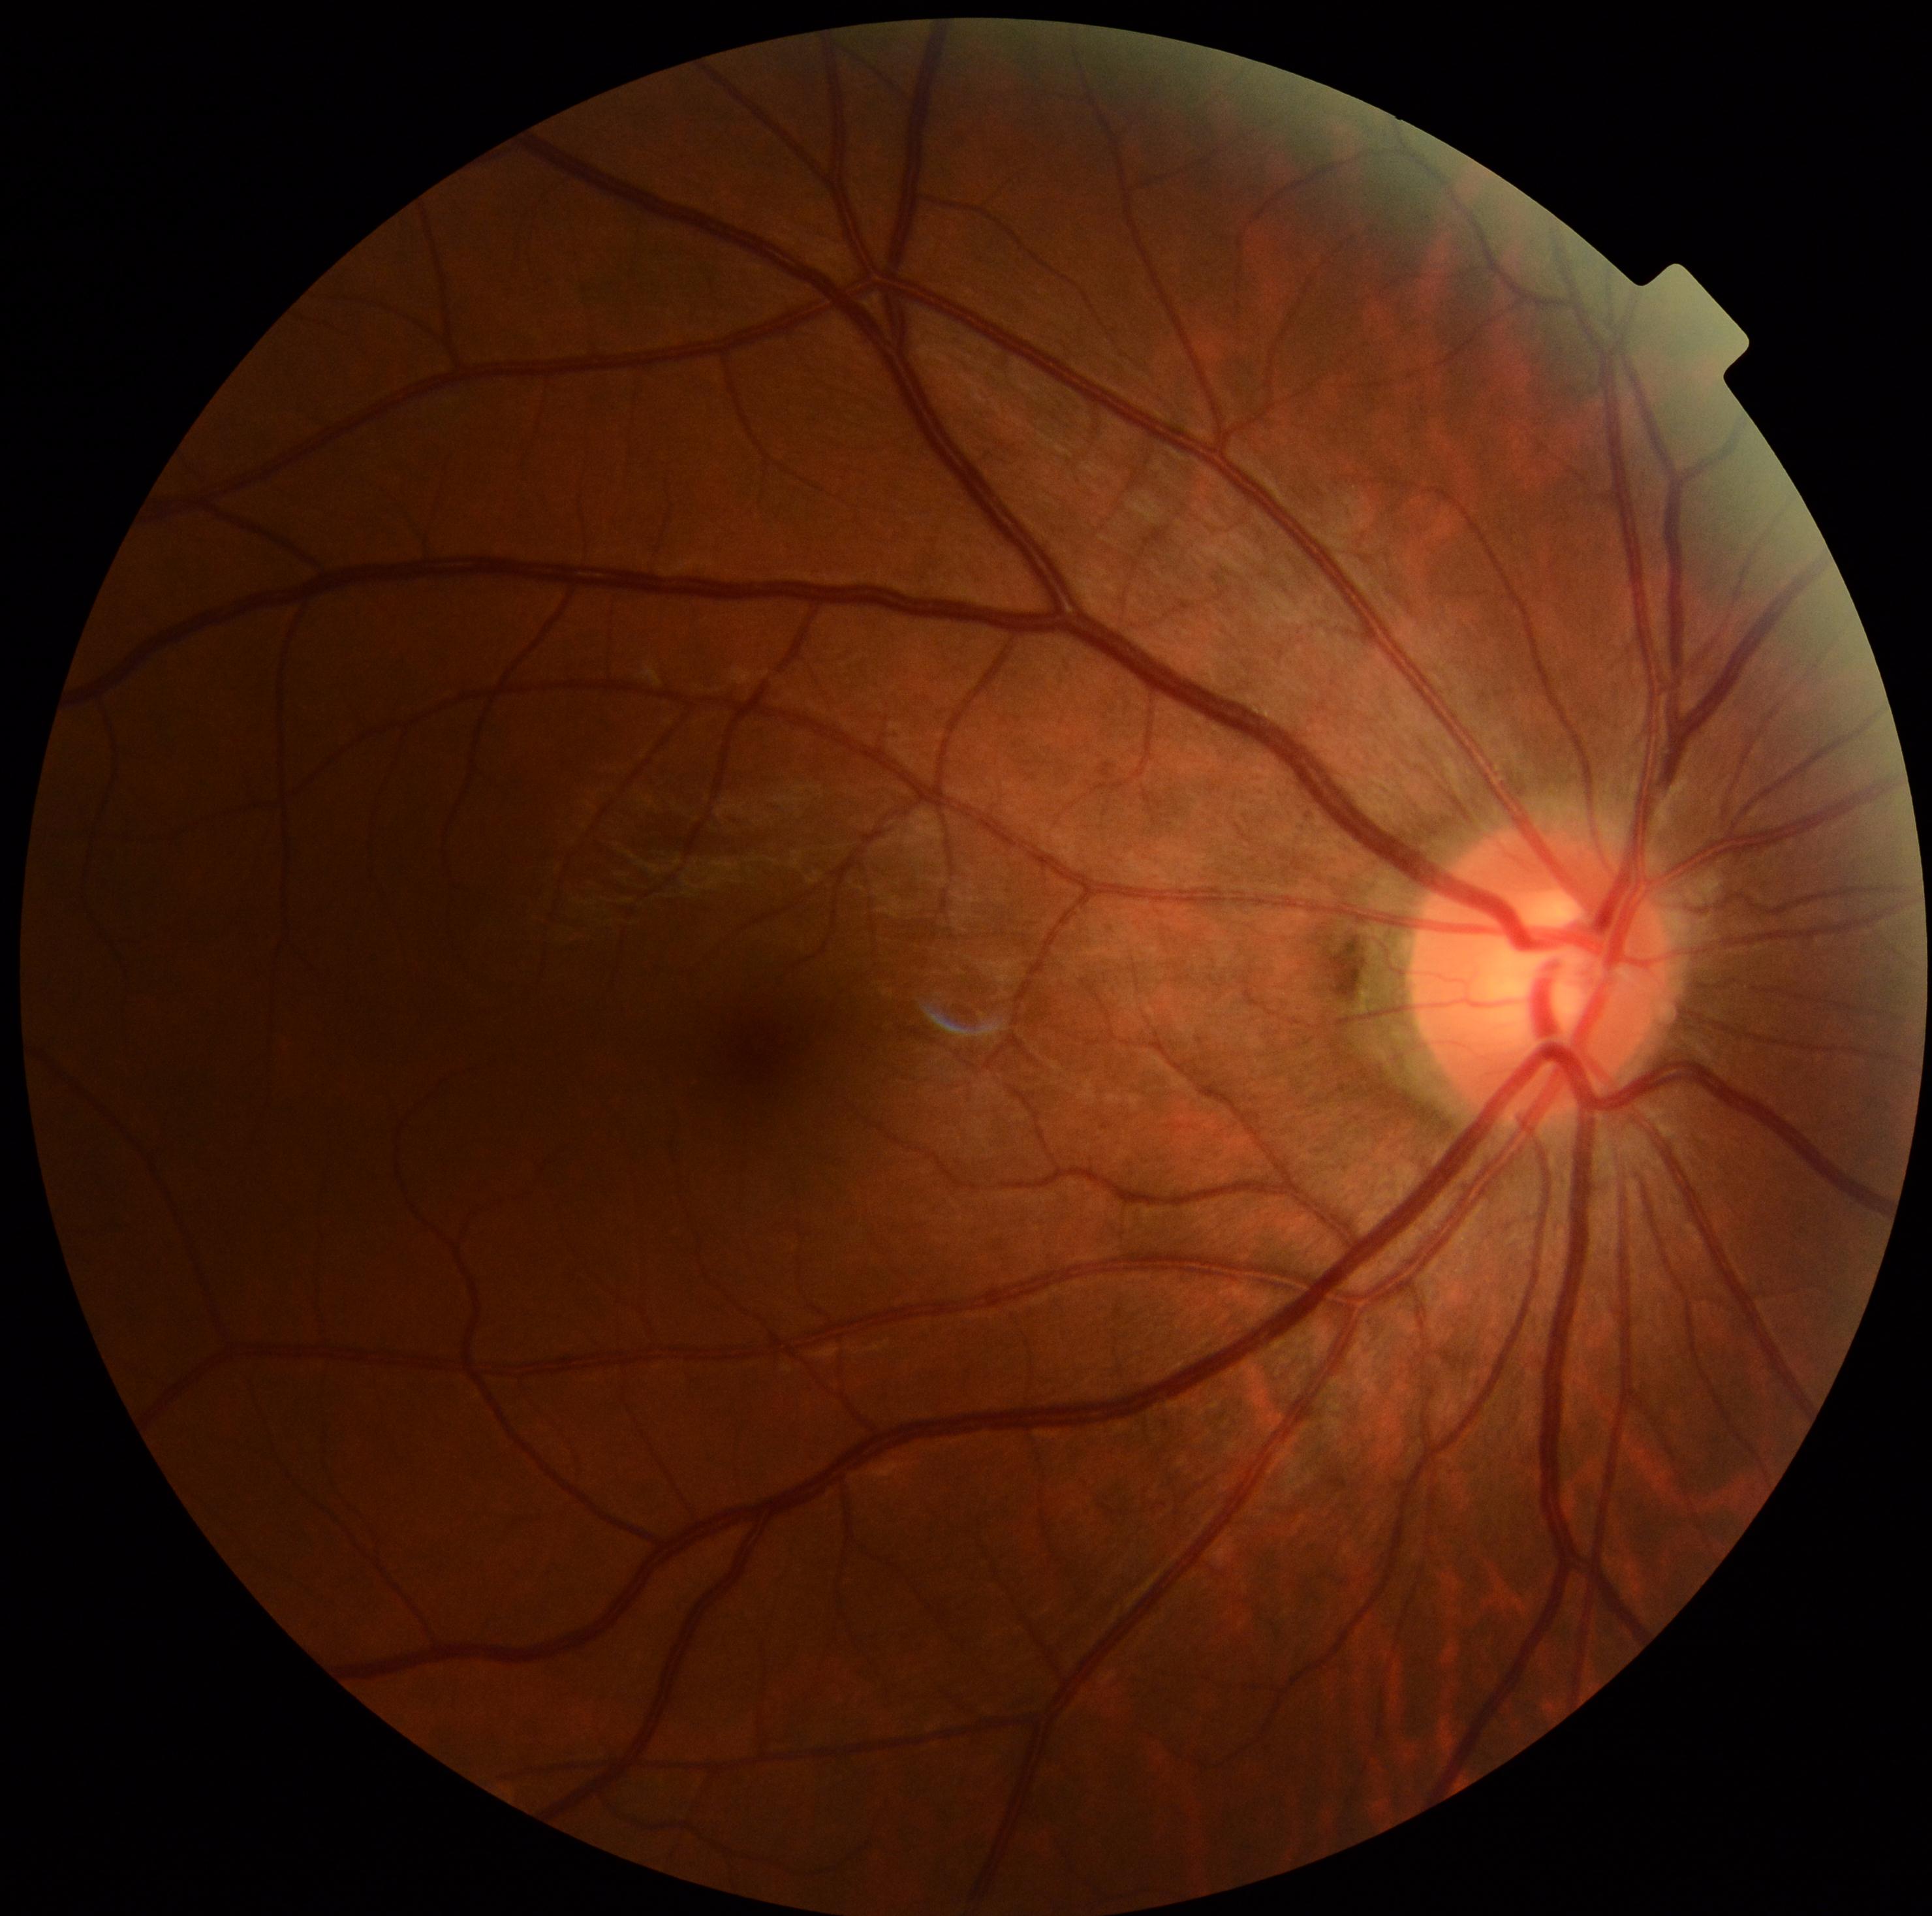
DR severity: 0/4.